45° FOV; color fundus photograph — 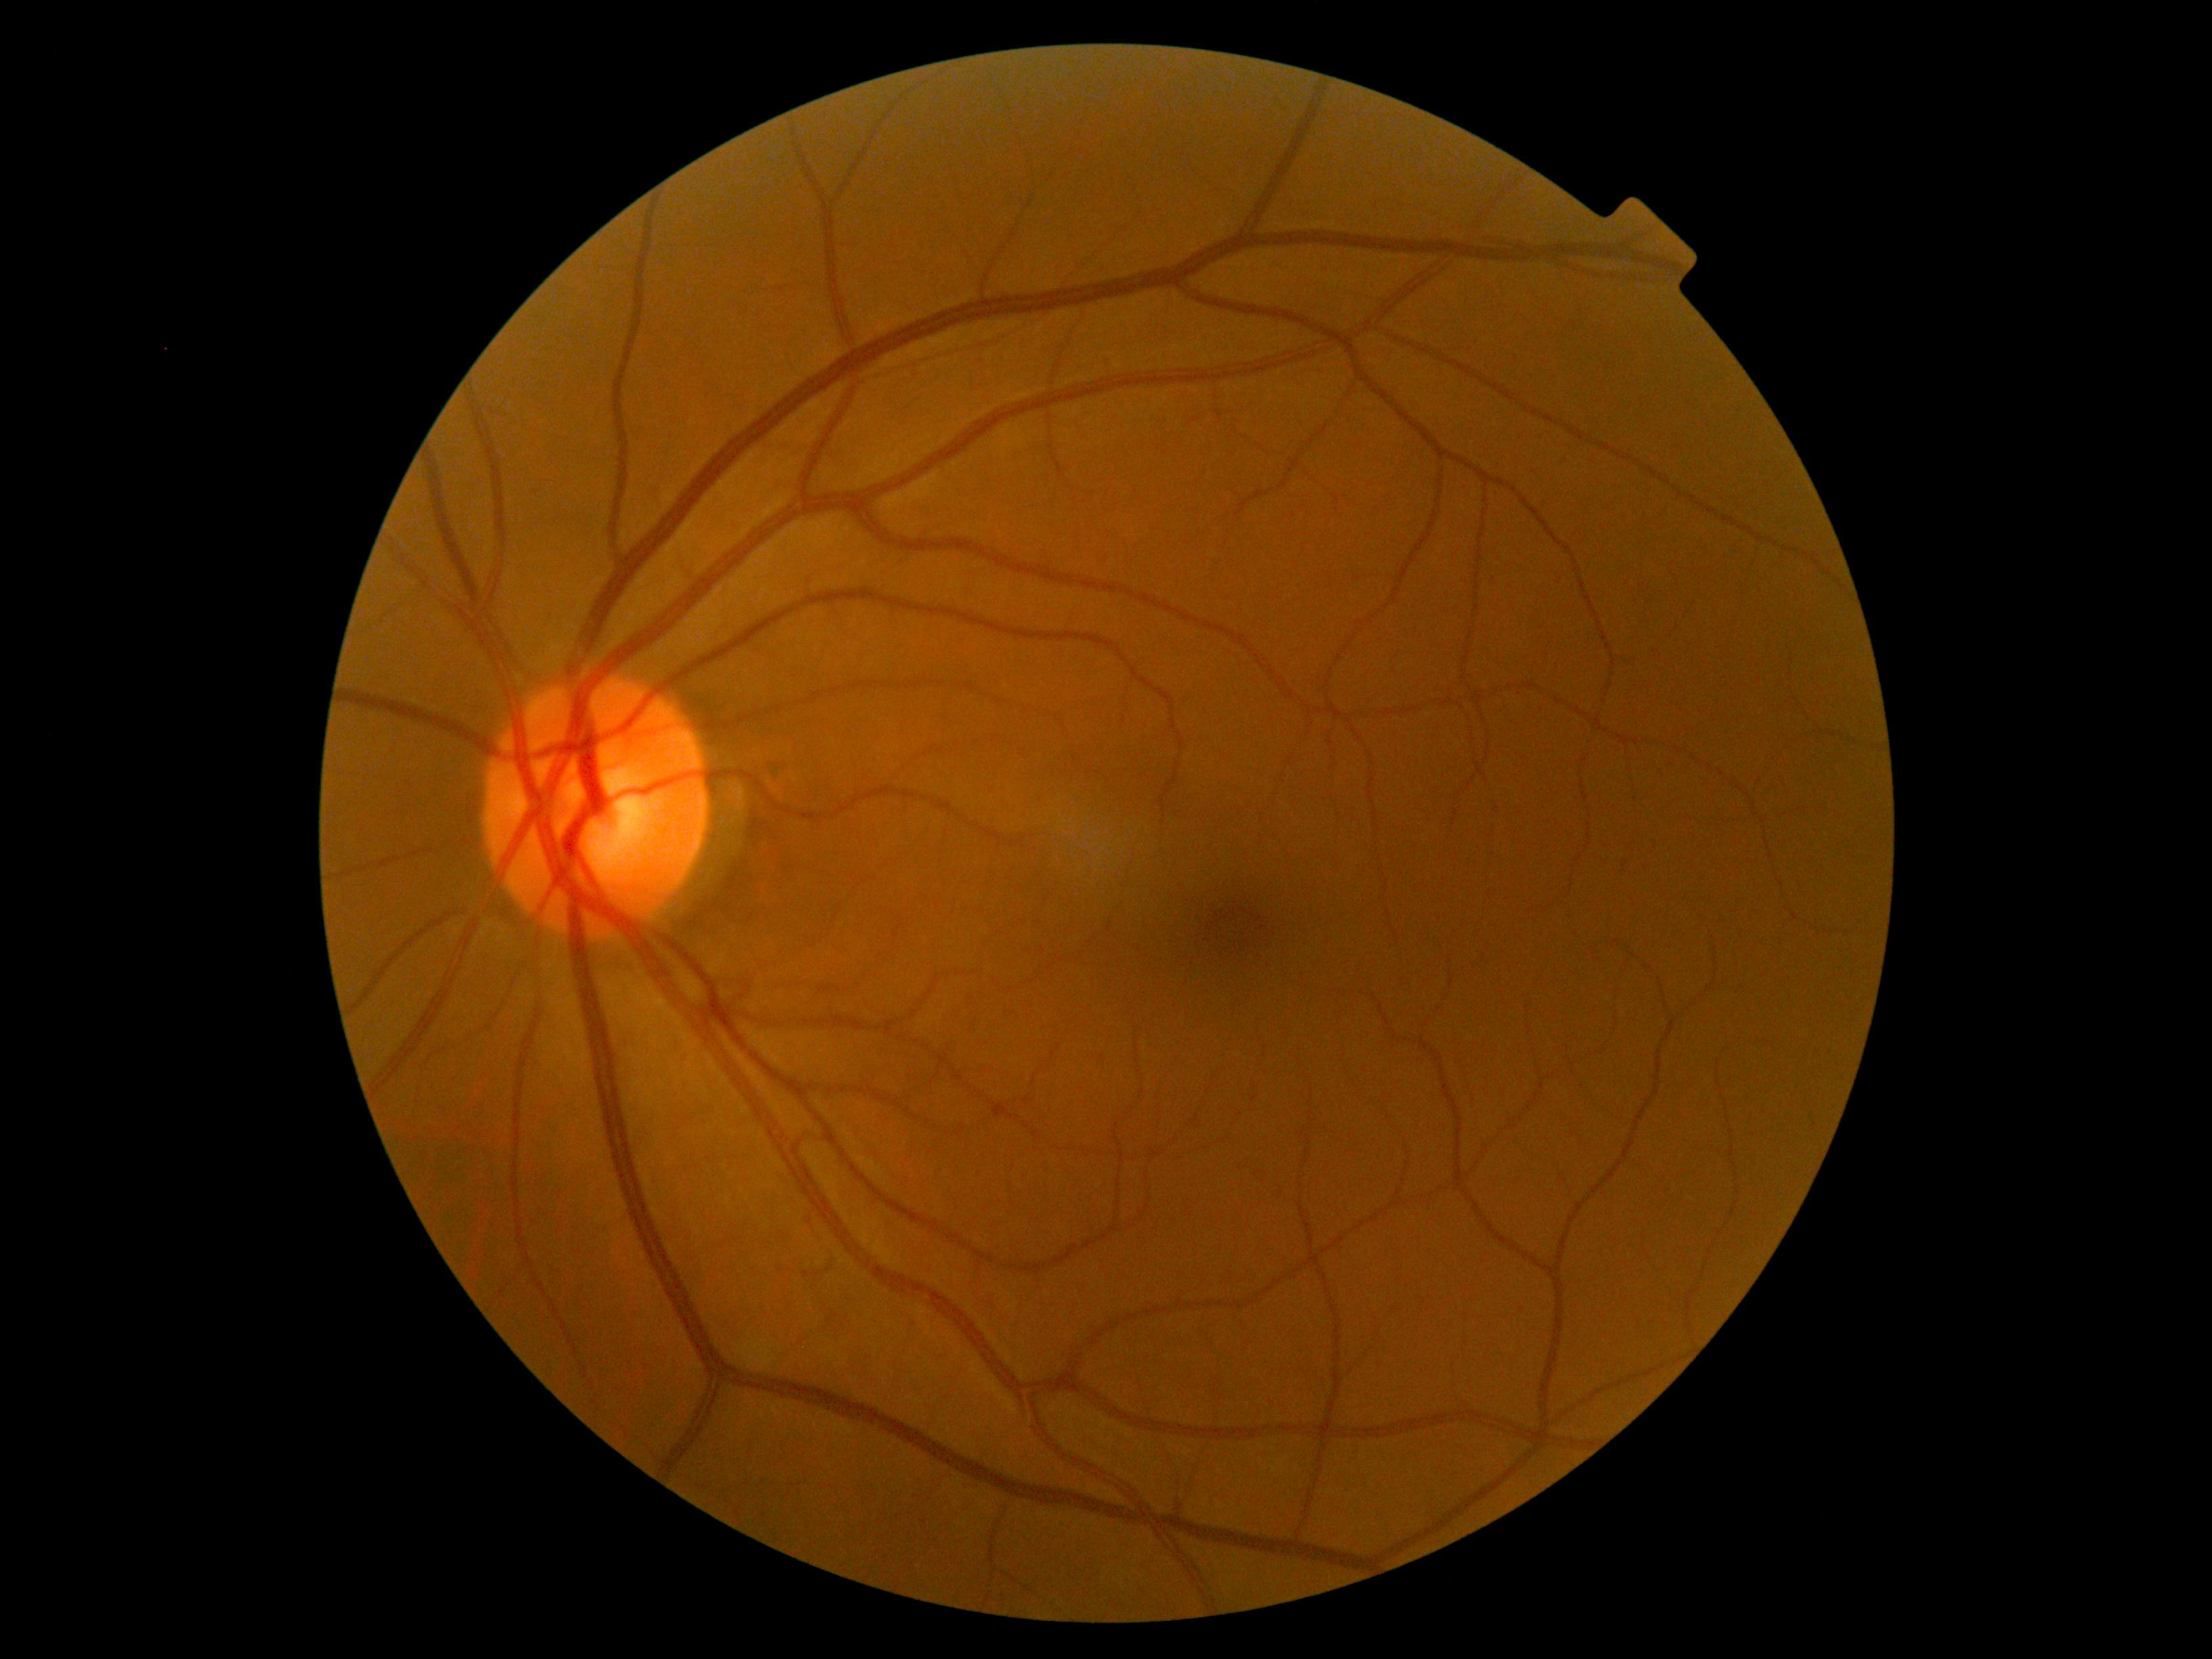
{"dr_grade": "no apparent diabetic retinopathy (grade 0)"}